Modified Davis grading; acquired with a NIDEK AFC-230; 848x848px: 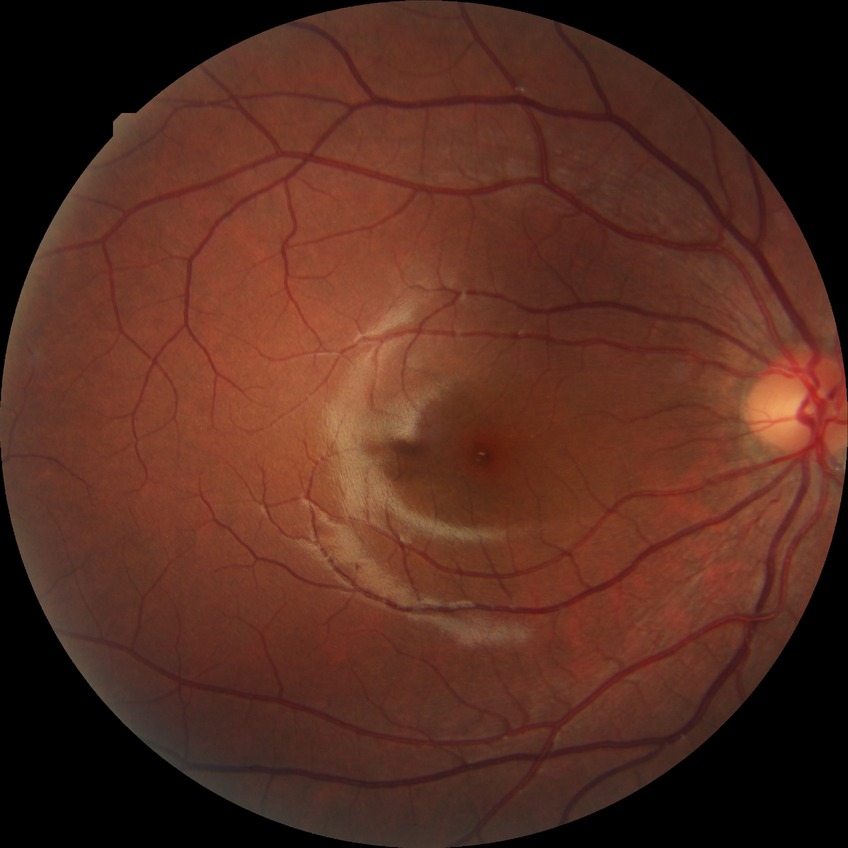 Diabetic retinopathy (DR): NDR (no diabetic retinopathy).